DR severity per modified Davis staging. 848x848px:
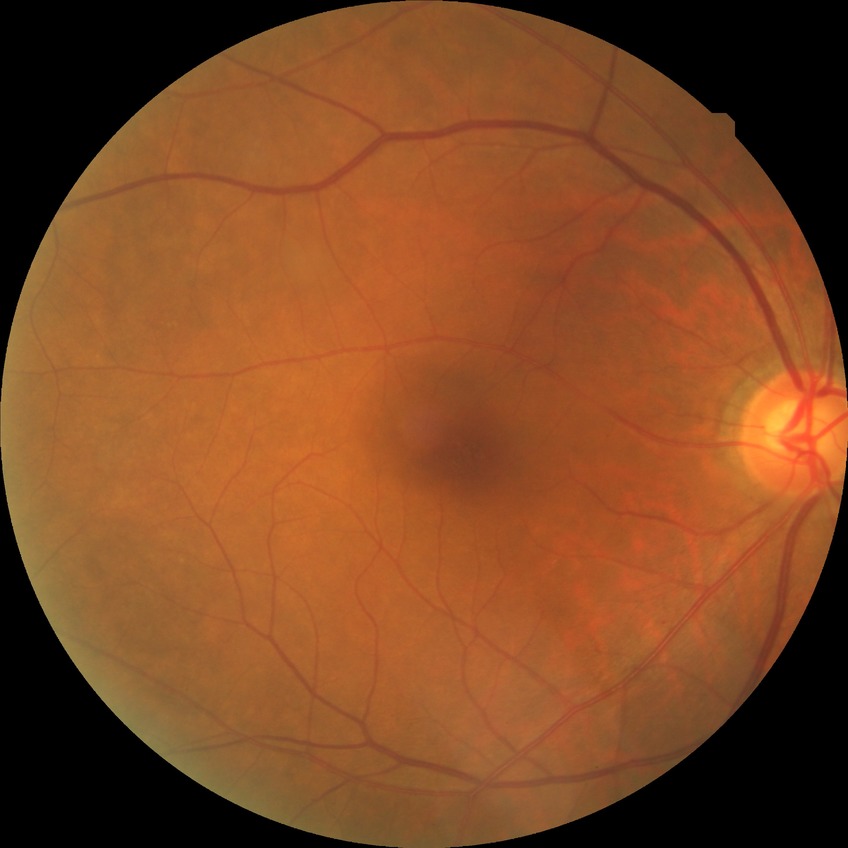 Diabetic retinopathy severity is no diabetic retinopathy.